Wide-field contact fundus photograph of an infant
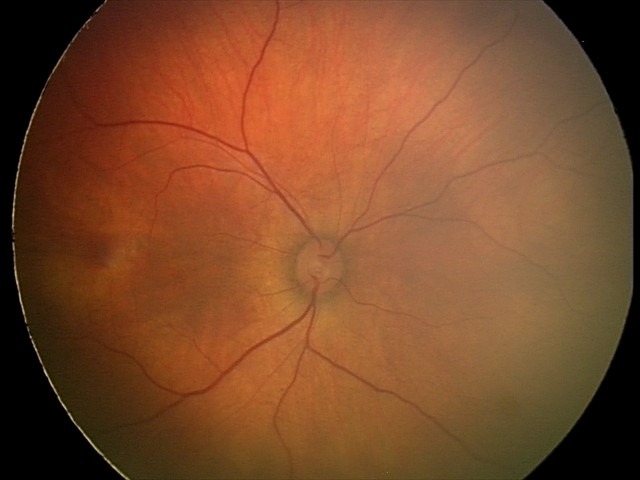

Diagnosis from this screening exam: retinal hemorrhages.